Image size 2352x1568.
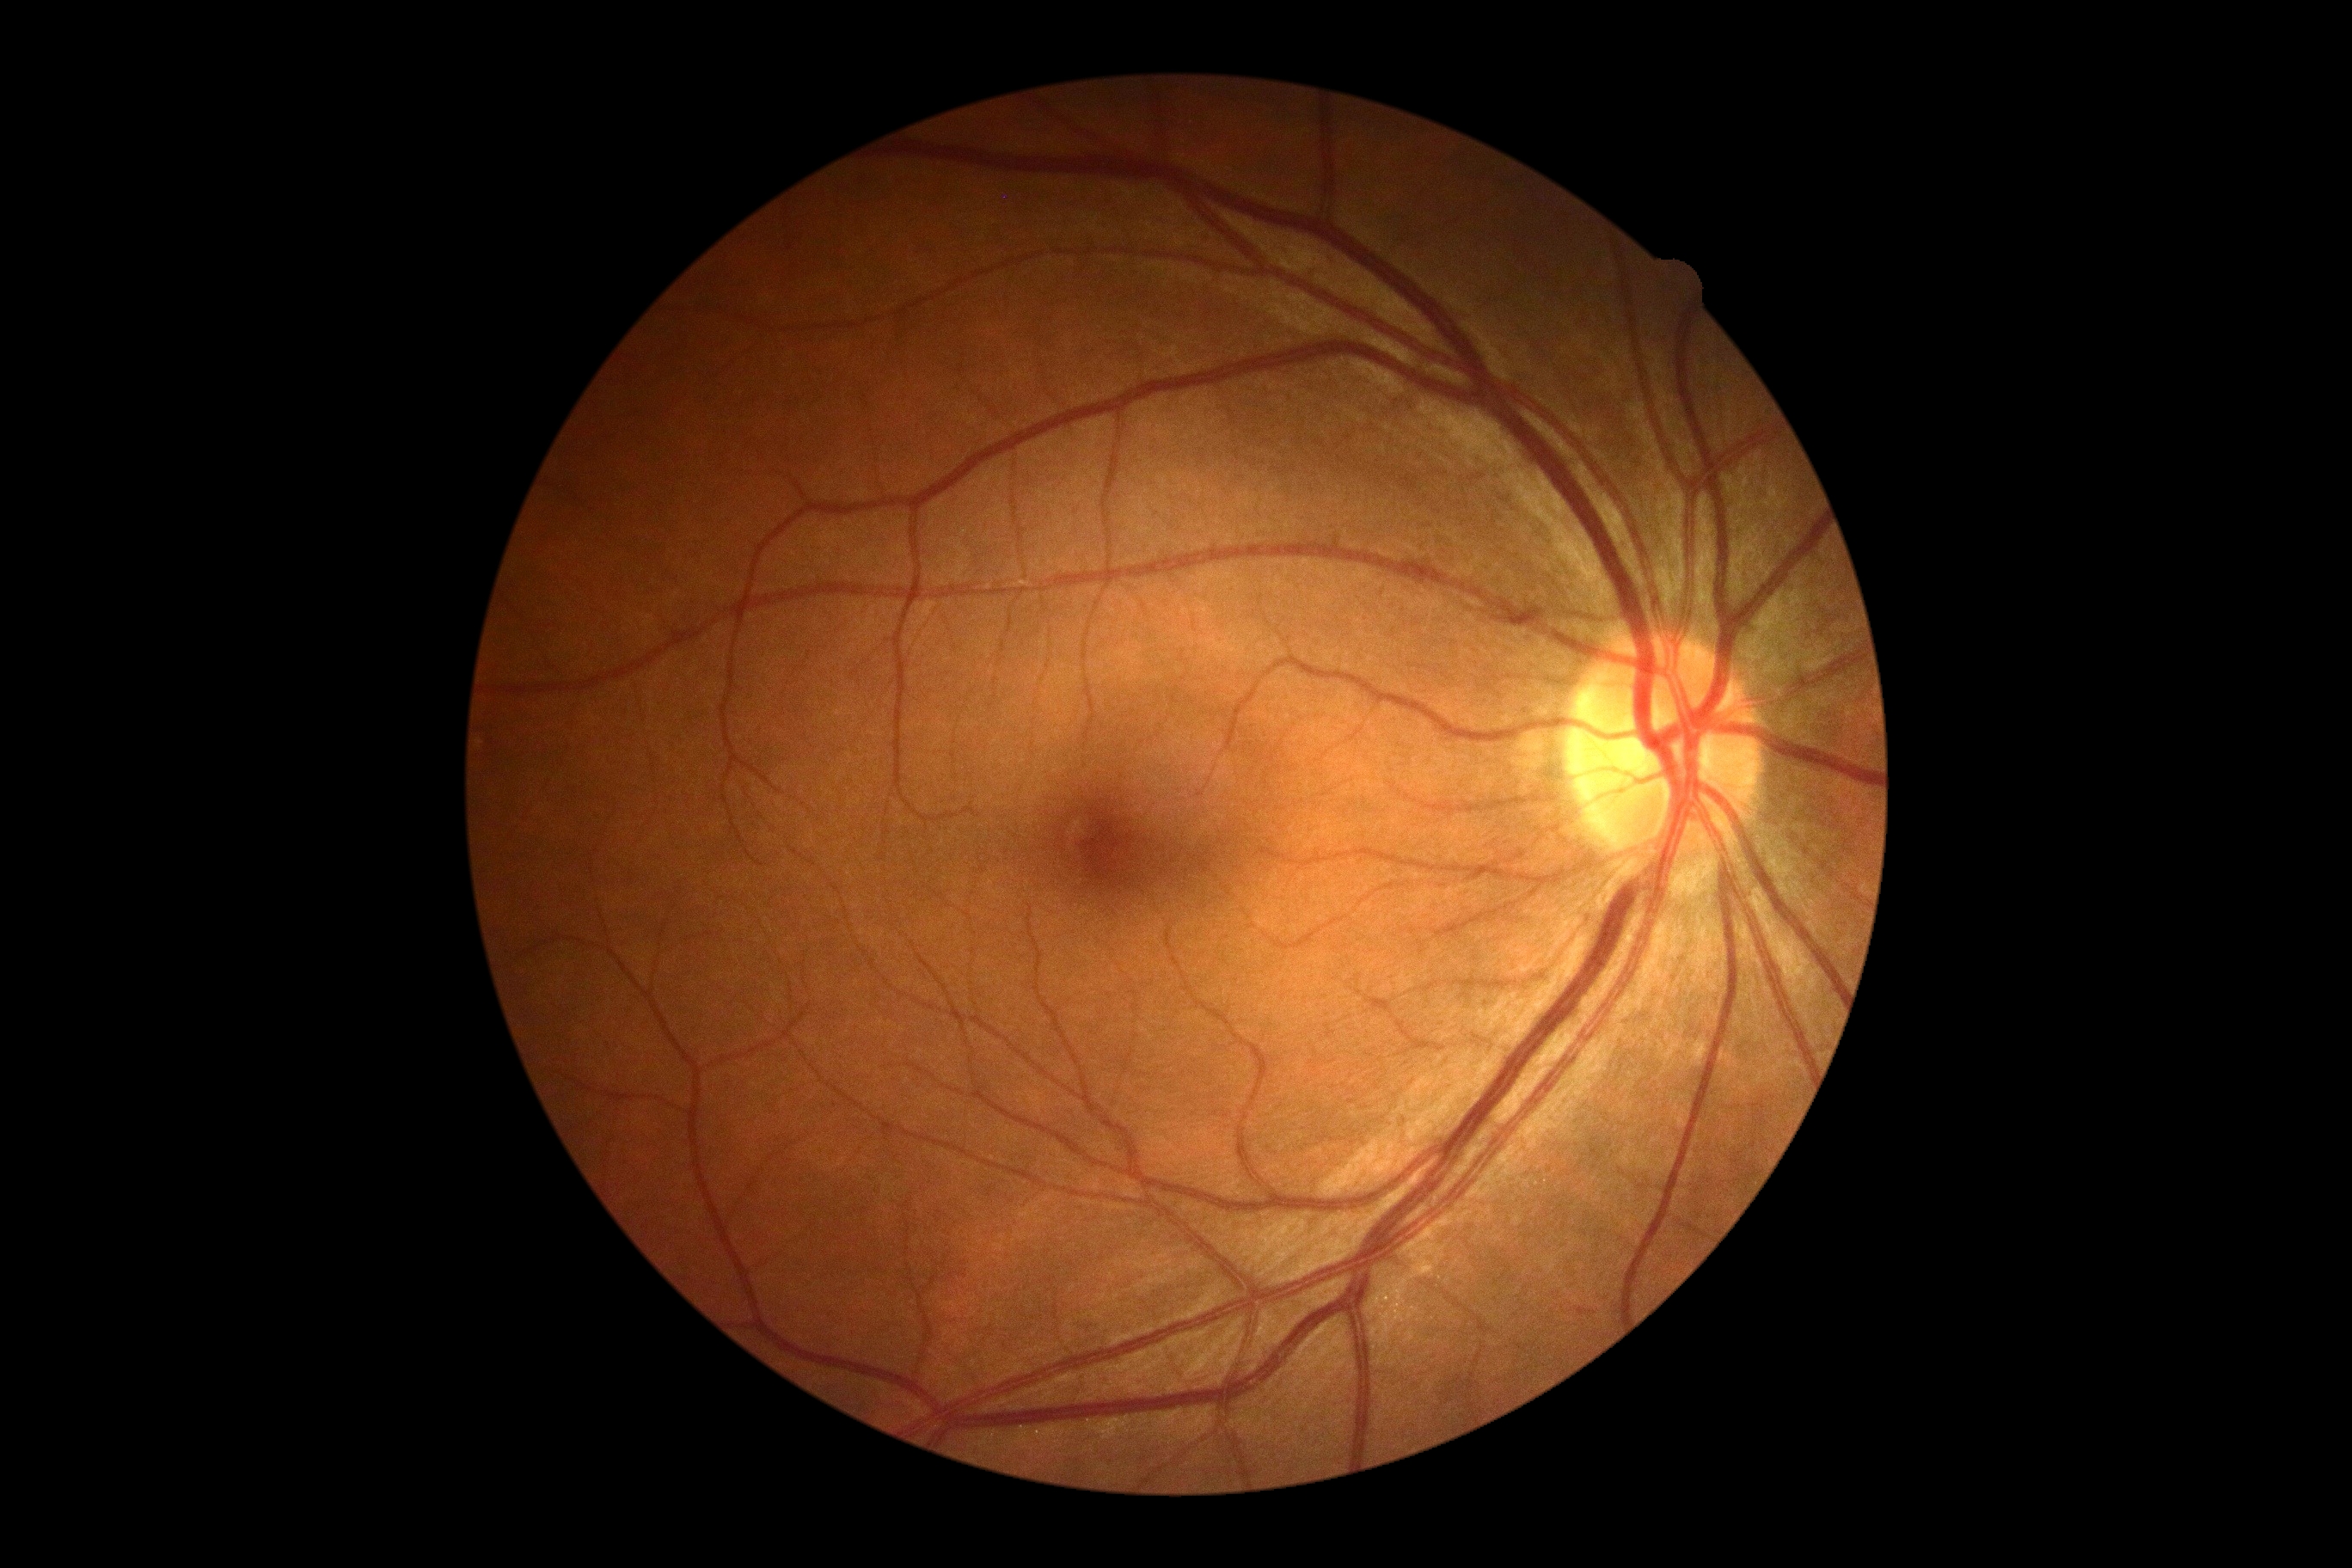

Diabetic retinopathy grade is no apparent retinopathy (0) — no visible signs of diabetic retinopathy.